No pharmacologic dilation, NIDEK AFC-230 — 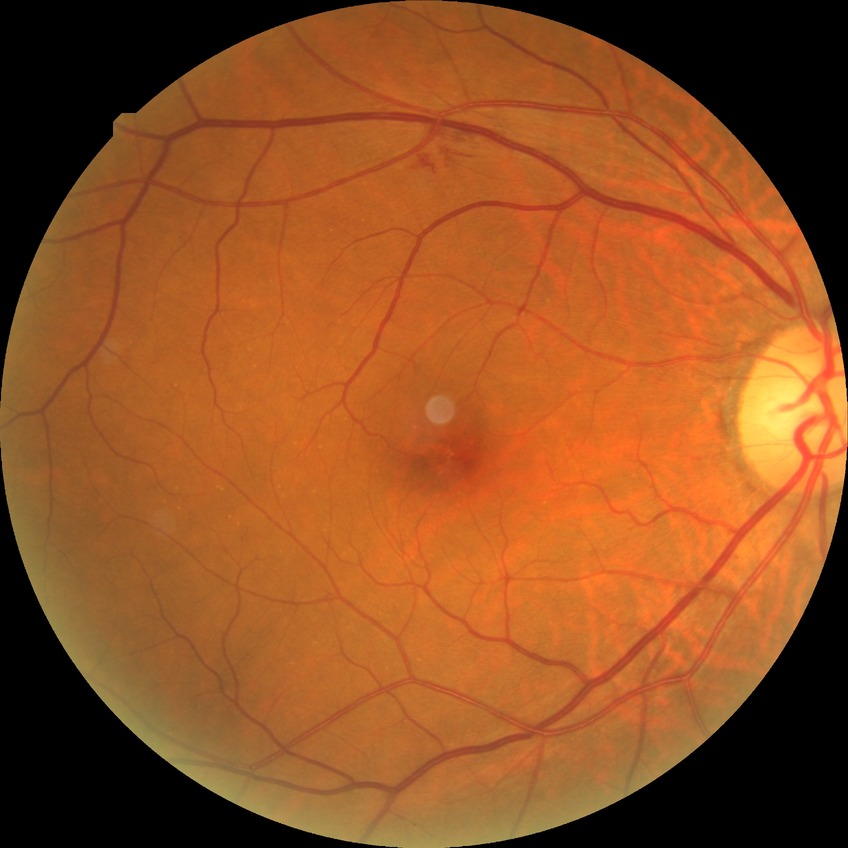

DR: NDR. No signs of diabetic retinopathy.